Wide-field contact fundus photograph of an infant · 640x480: 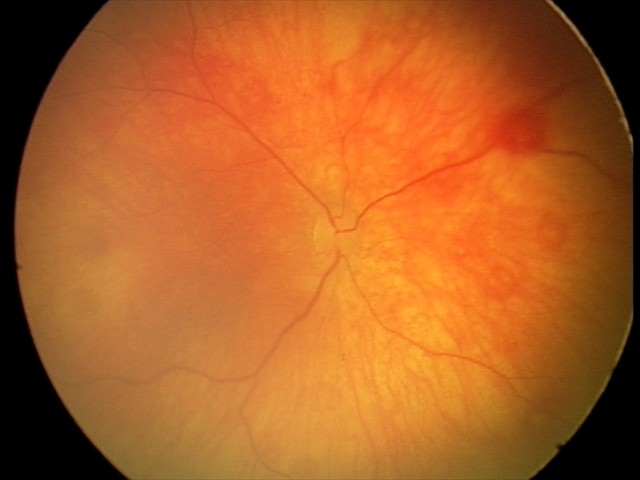
Examination with physiological retinal findings.